Pediatric wide-field fundus photograph.
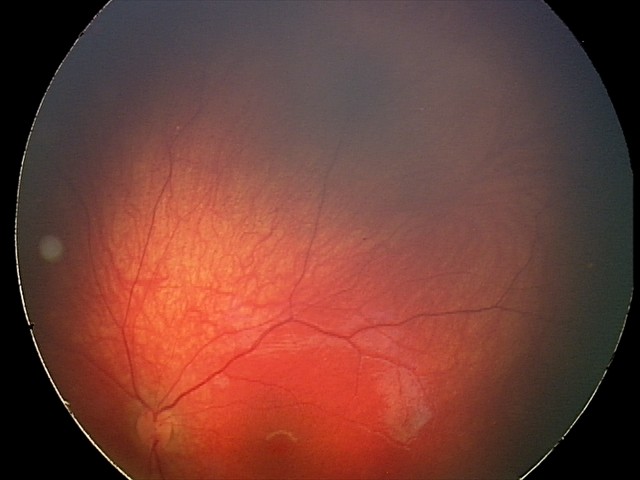
Diagnosis from this screening exam: retinal astrocytic hamartoma.